Image size 848x848, nonmydriatic.
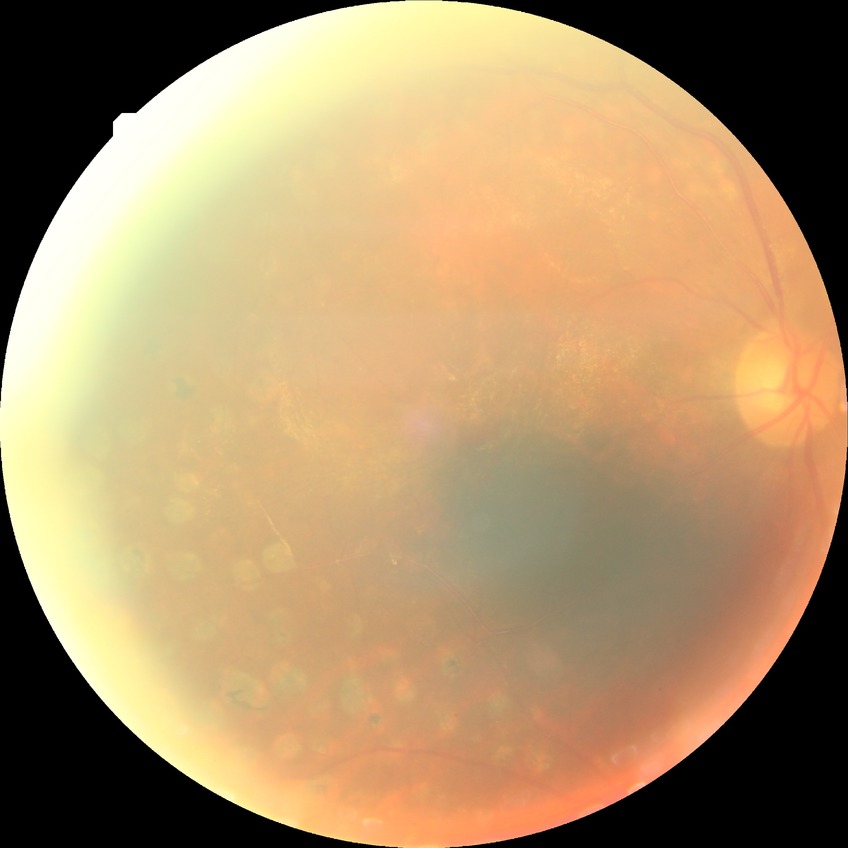
diabetic retinopathy (DR): proliferative diabetic retinopathy (PDR).